Diabetic retinopathy graded by the modified Davis classification: 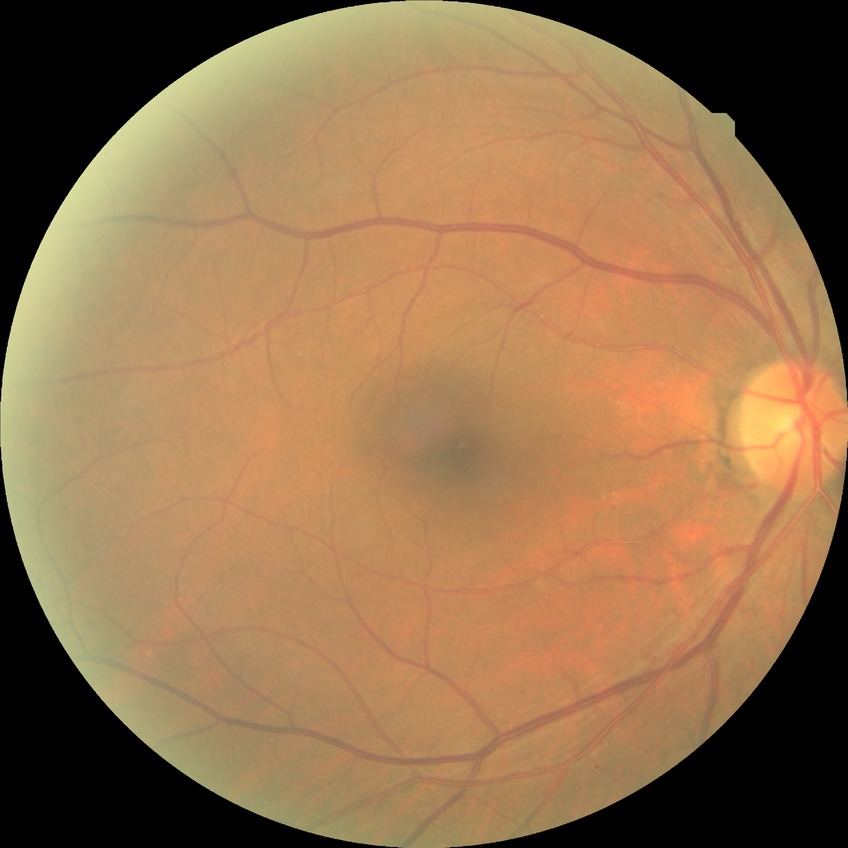
Diabetic retinopathy (DR) is NDR (no diabetic retinopathy).